45-degree field of view. 848 by 848 pixels
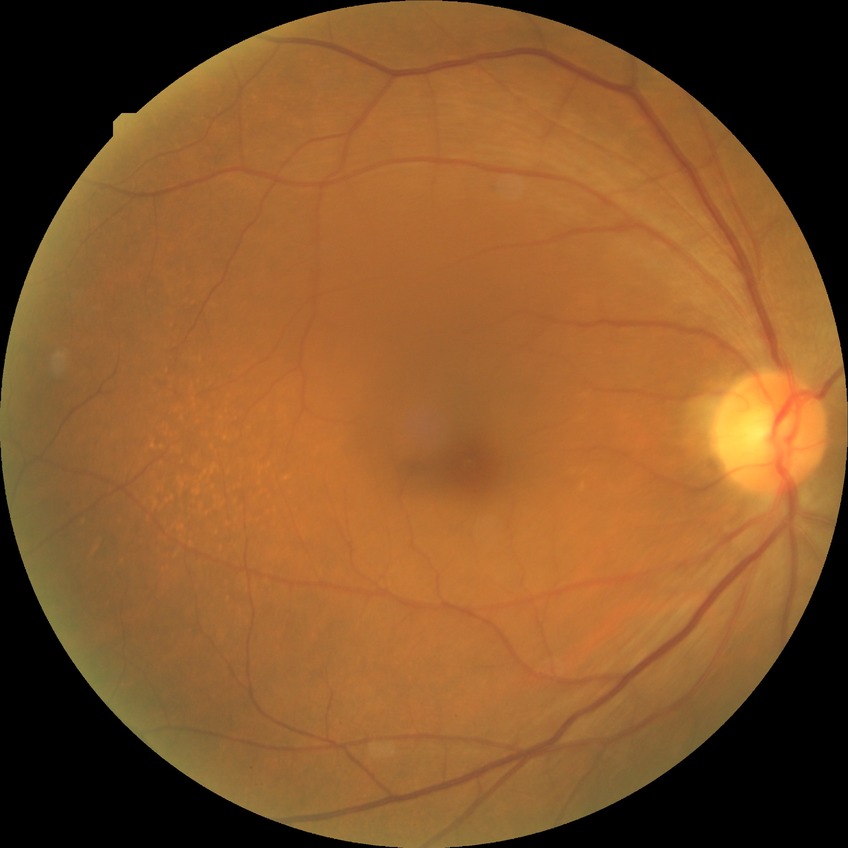

davis_grade: no diabetic retinopathy